2350x1568. 45-degree field of view. Color fundus photograph: 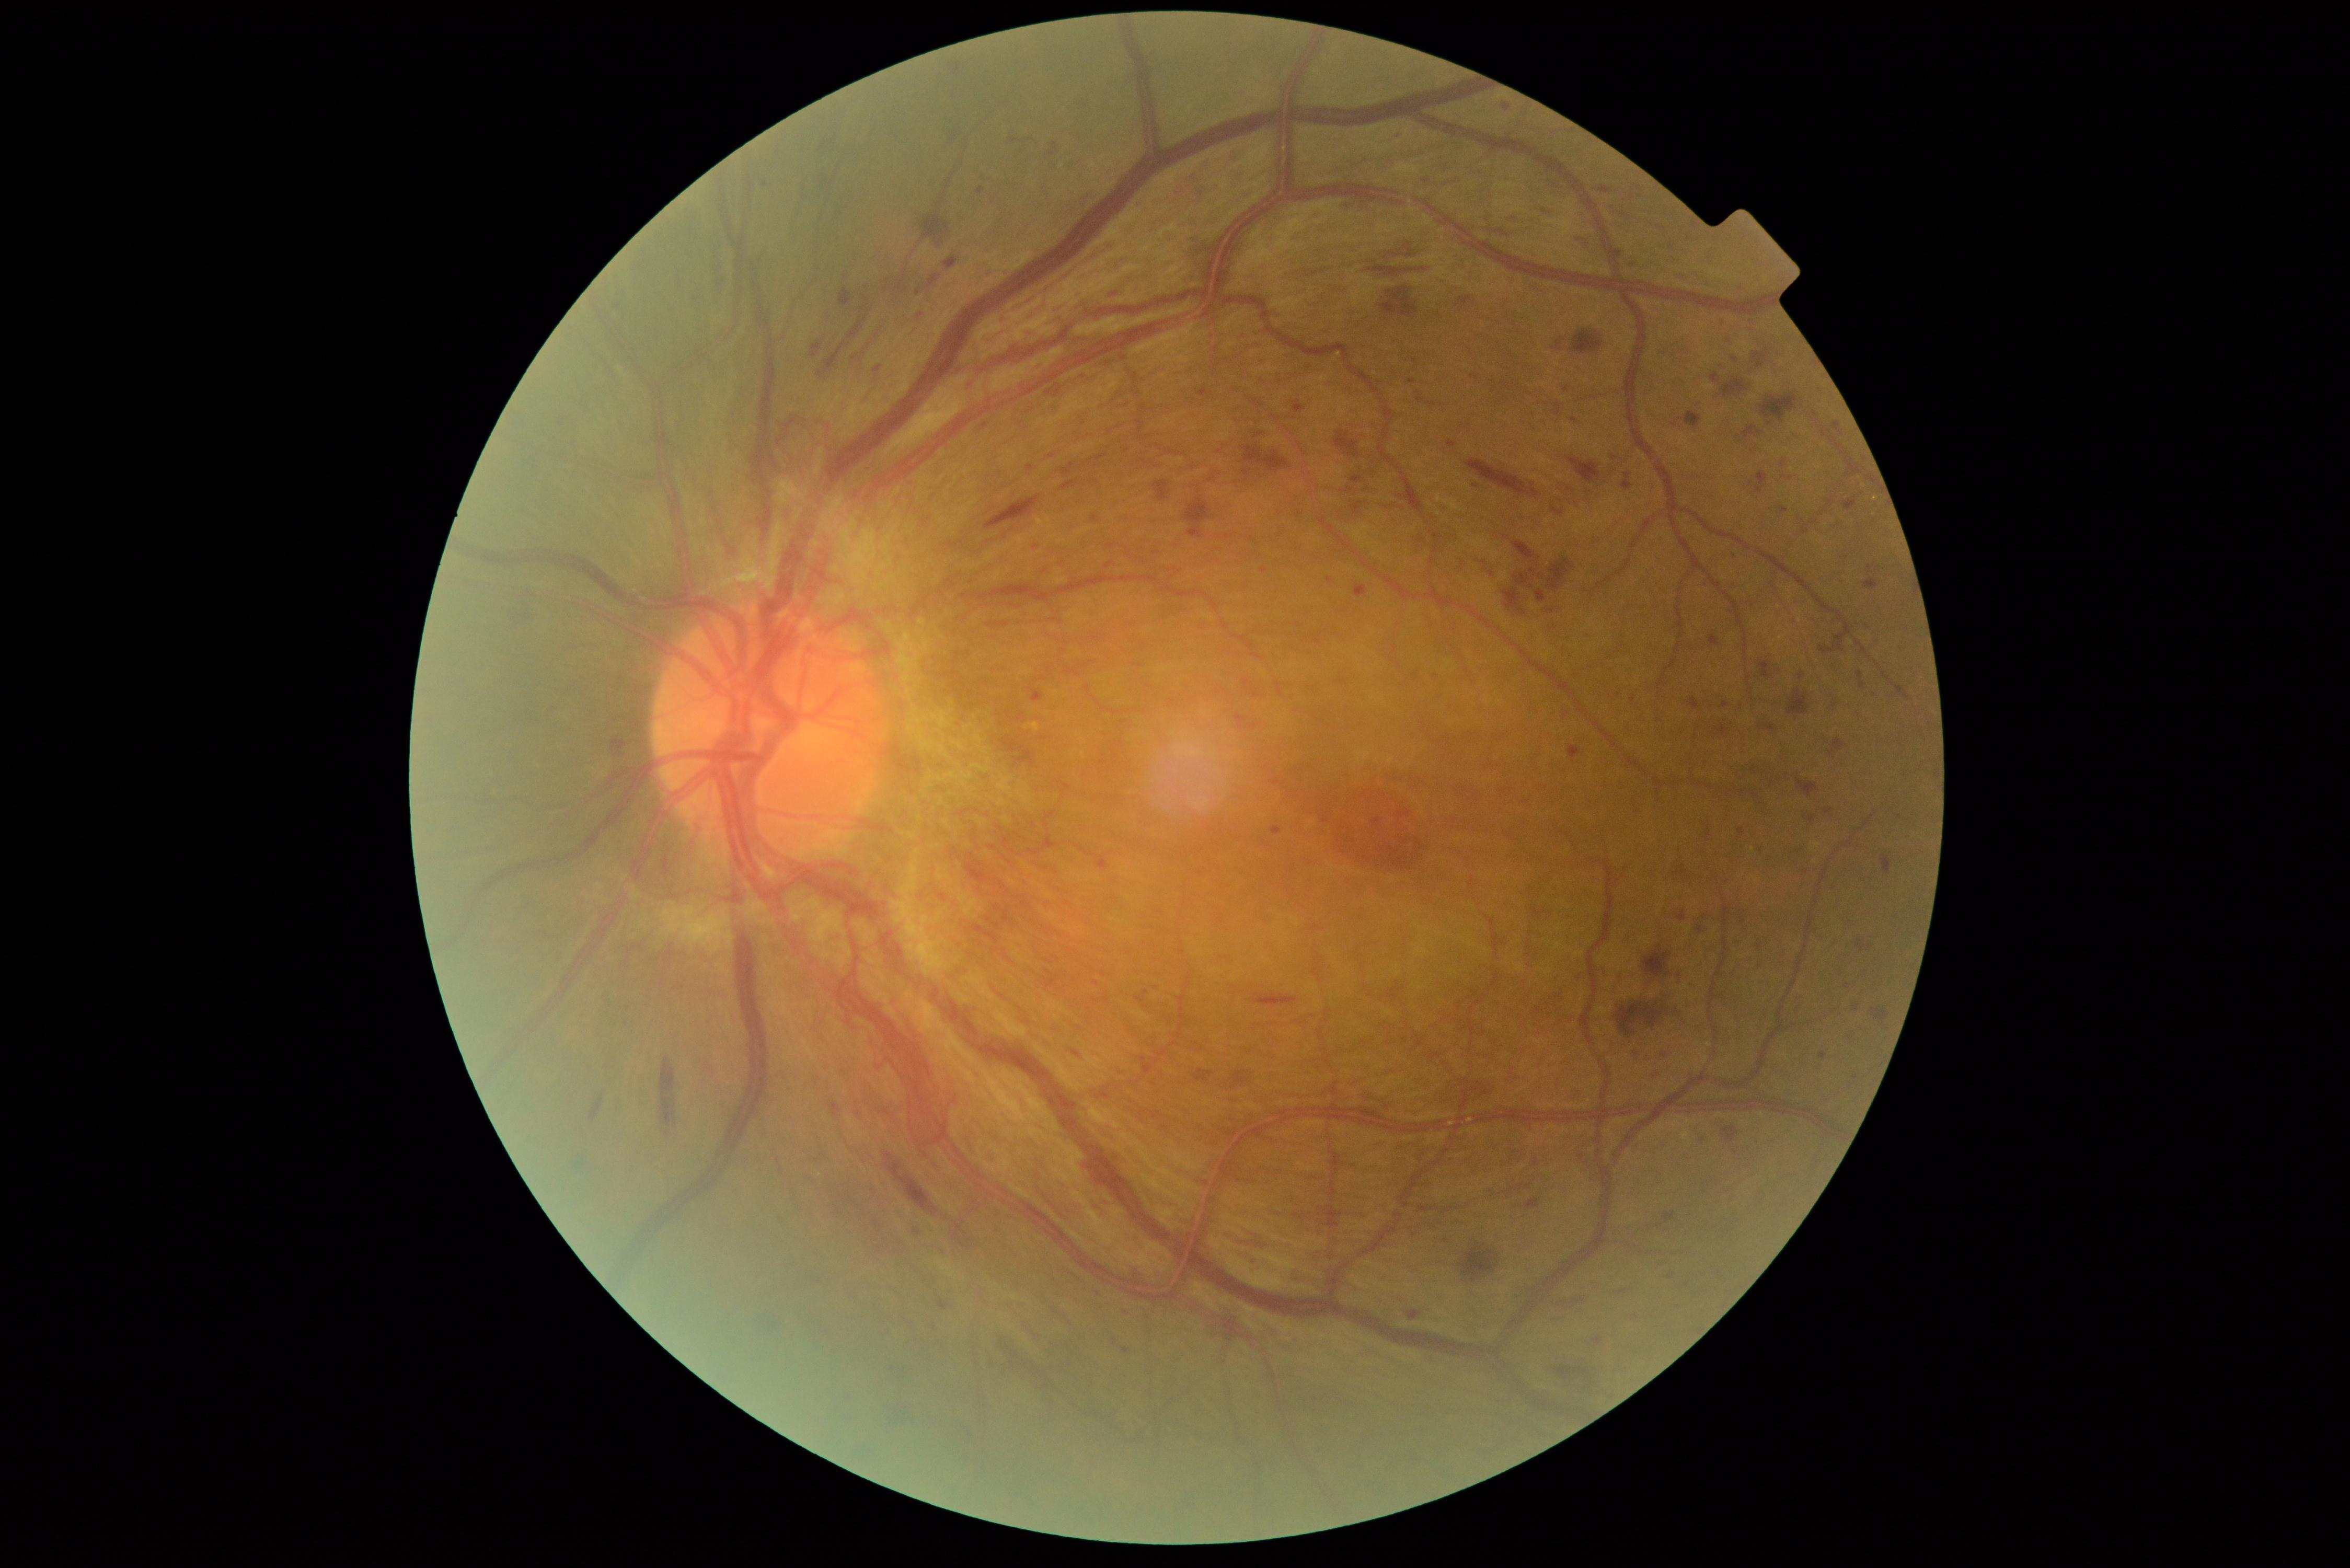
<lesions partial="true">
  <dr_grade>4</dr_grade>
  <ma partial="true">1351/476/1364/483; 1372/817/1383/827; 1293/403/1306/413; 1248/724/1260/730; 1105/562/1114/569</ma>
  <ma_small_approx>[1299, 515]; [1030, 469]; [985, 426]; [1705, 916]; [918, 1232]; [1399, 136]; [1598, 1341]; [1725, 704]; [765, 185]; [921, 315]; [1856, 1008]</ma_small_approx>
  <he partial="true">1379/287/1419/317; 1614/967/1623/993; 1873/1009/1888/1026; 1536/590/1547/604; 1093/362/1117/370; 1062/480/1078/492; 1457/296/1471/307; 1663/1050/1670/1058; 1337/203/1353/211; 1743/427/1761/439; 1630/183/1643/188; 511/608/538/627; 1616/1002/1665/1037; 1822/635/1844/655; 961/1239/972/1248; 1154/480/1169/502; 824/342/846/372; 1351/502/1364/515; 964/854/993/885</he>
  <he_small_approx>[1687, 1284]</he_small_approx>
</lesions>